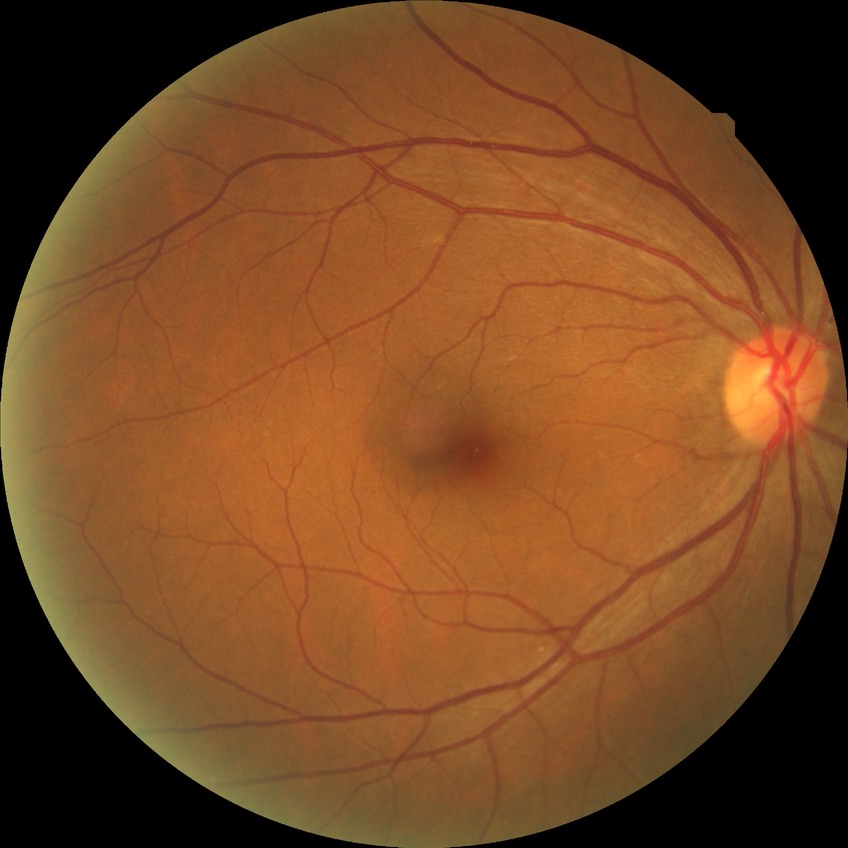 No apparent diabetic retinopathy. Davis DR grade: NDR.